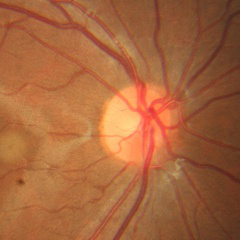

Glaucoma assessment = no glaucomatous findings.